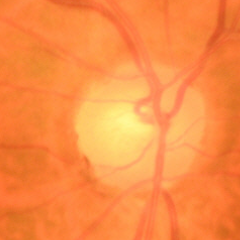

Fundus appearance consistent with early glaucoma.